848x848
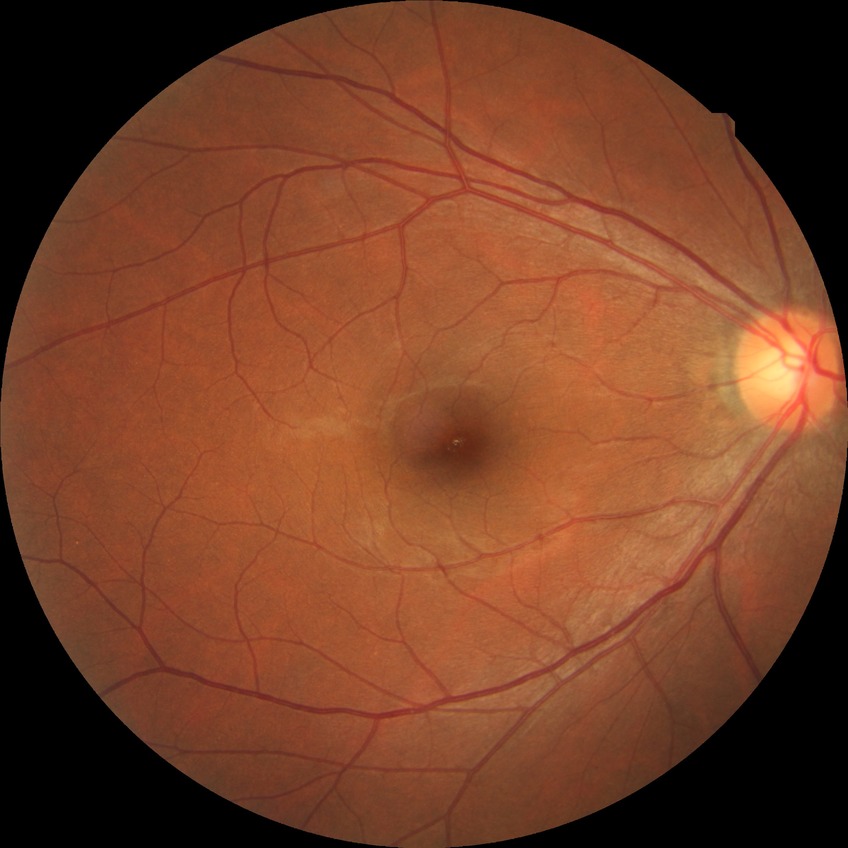

Modified Davis classification is no diabetic retinopathy.